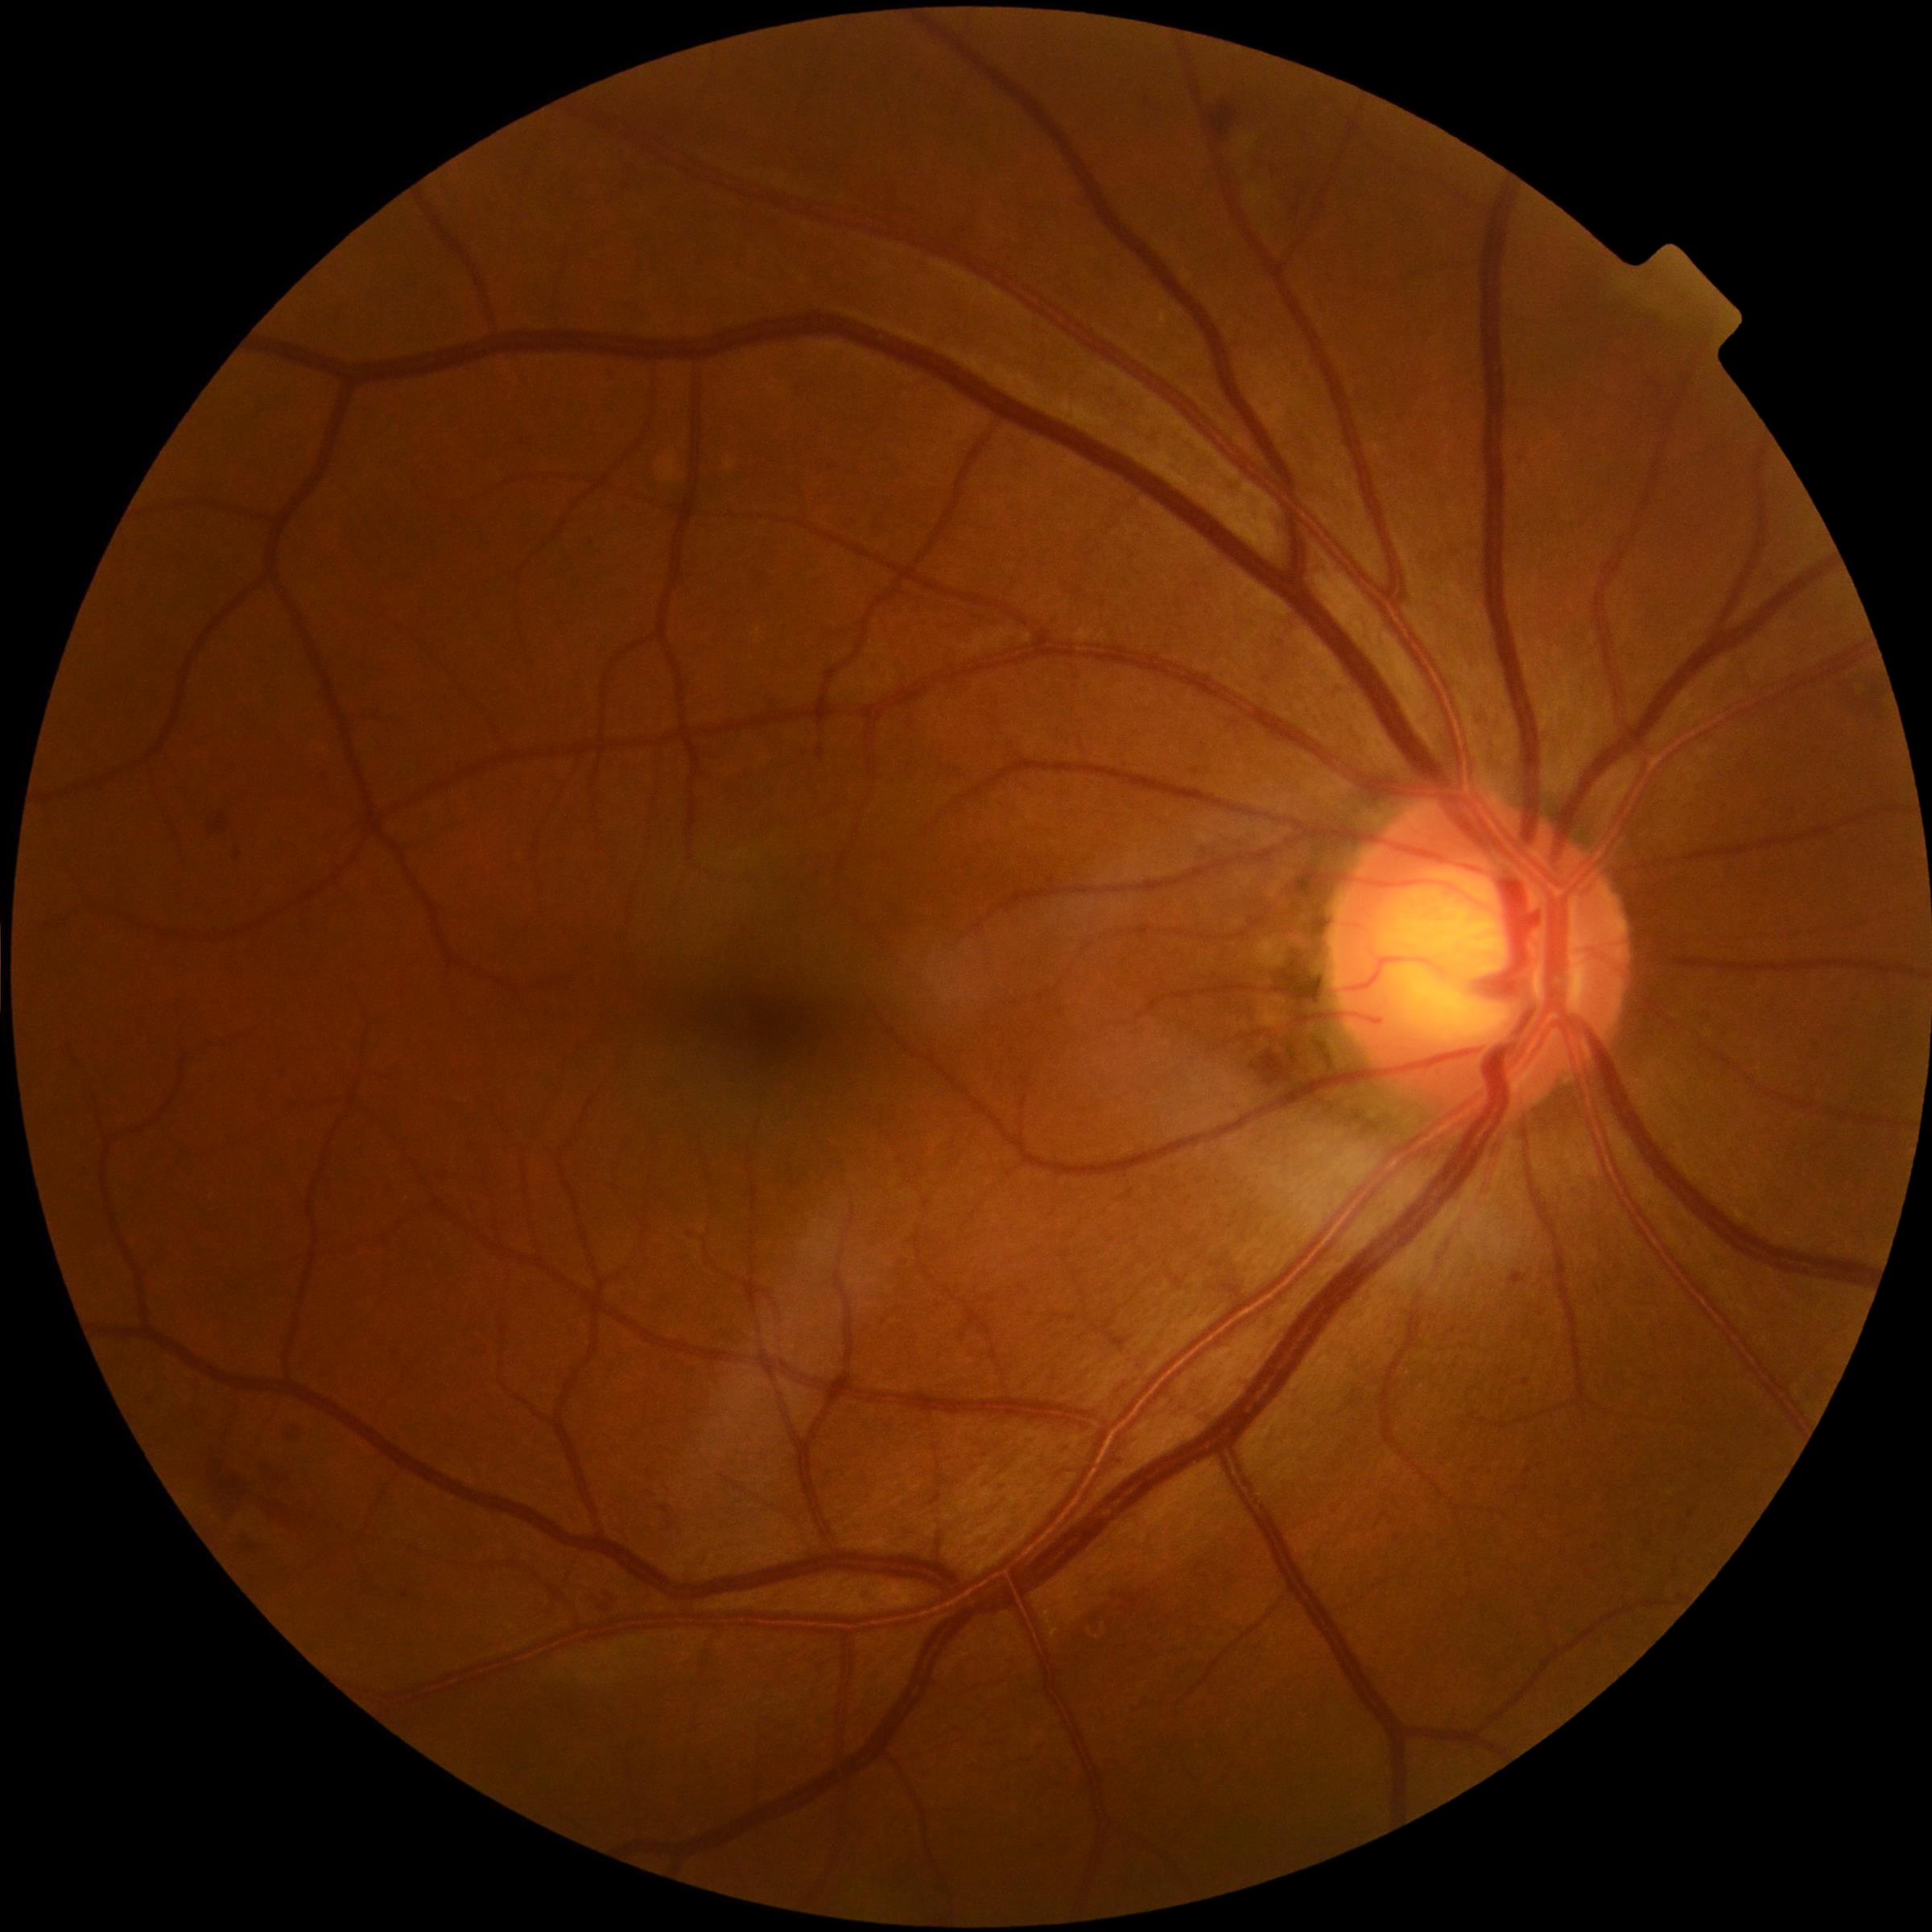

DR severity is moderate non-proliferative diabetic retinopathy (grade 2).